Color fundus image; 1932x1932px; captured after pupil dilation:
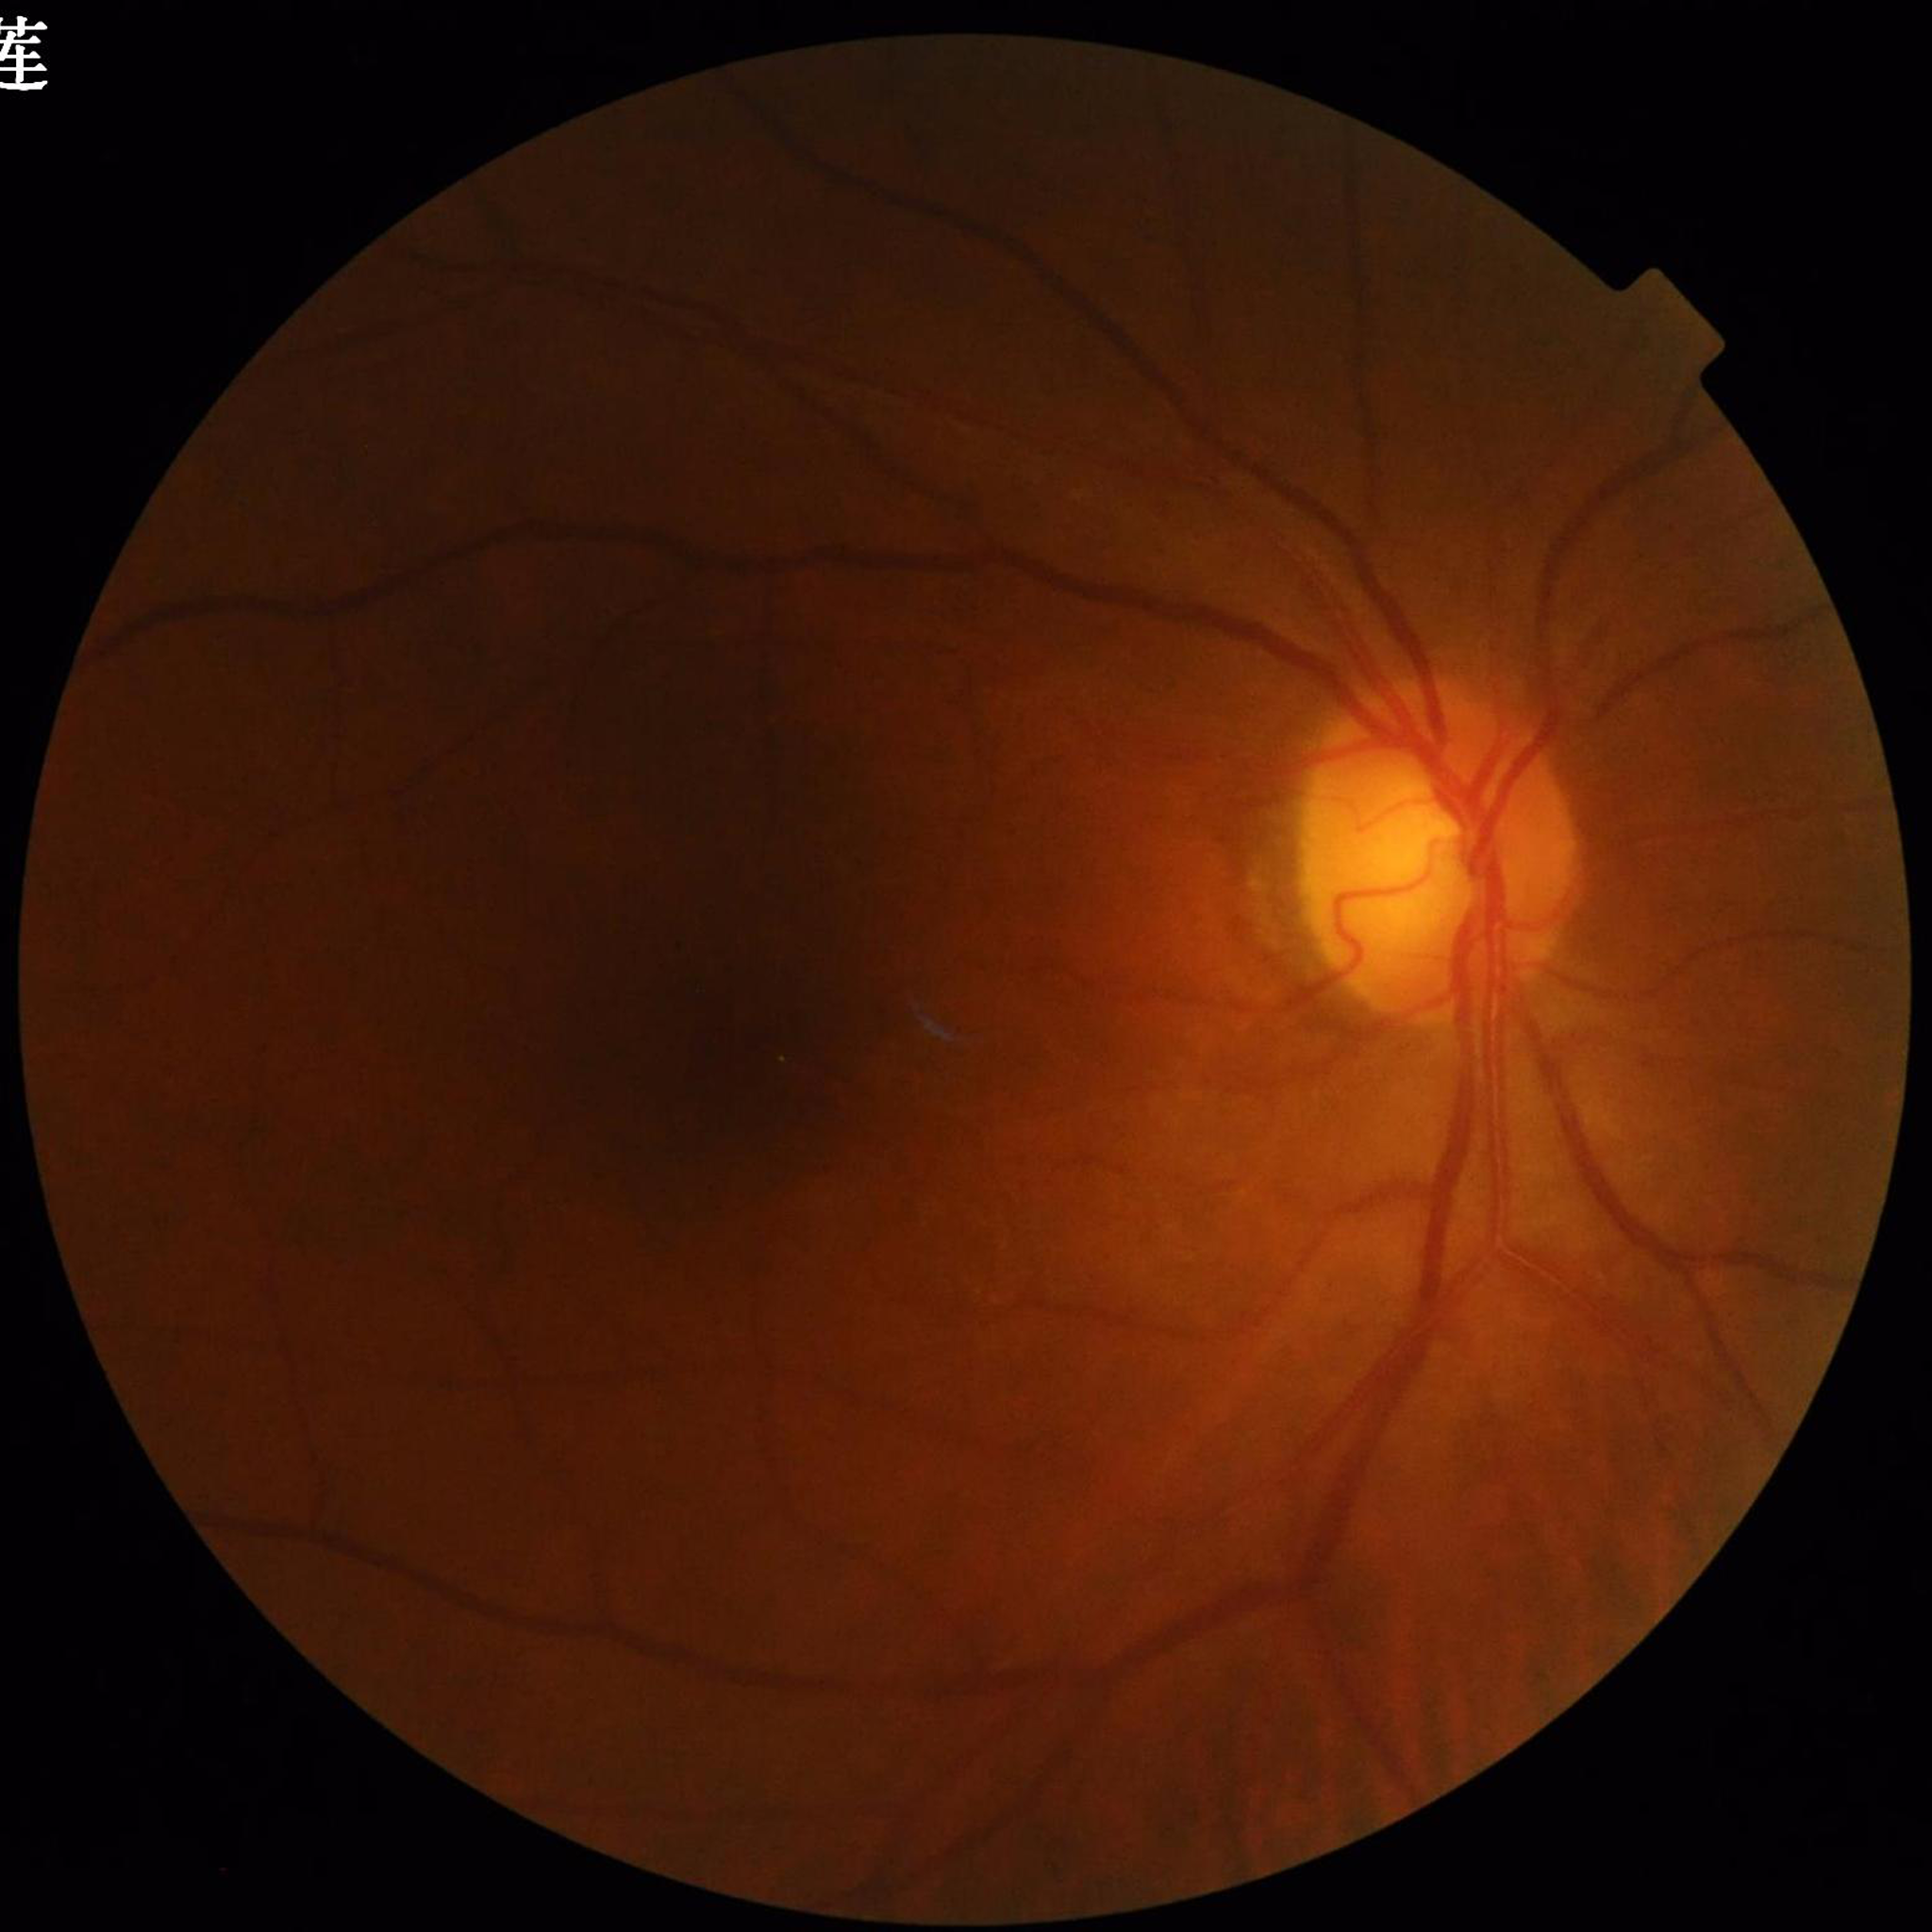 Eye affected by diabetic retinopathy.